CFP. 45-degree field of view:
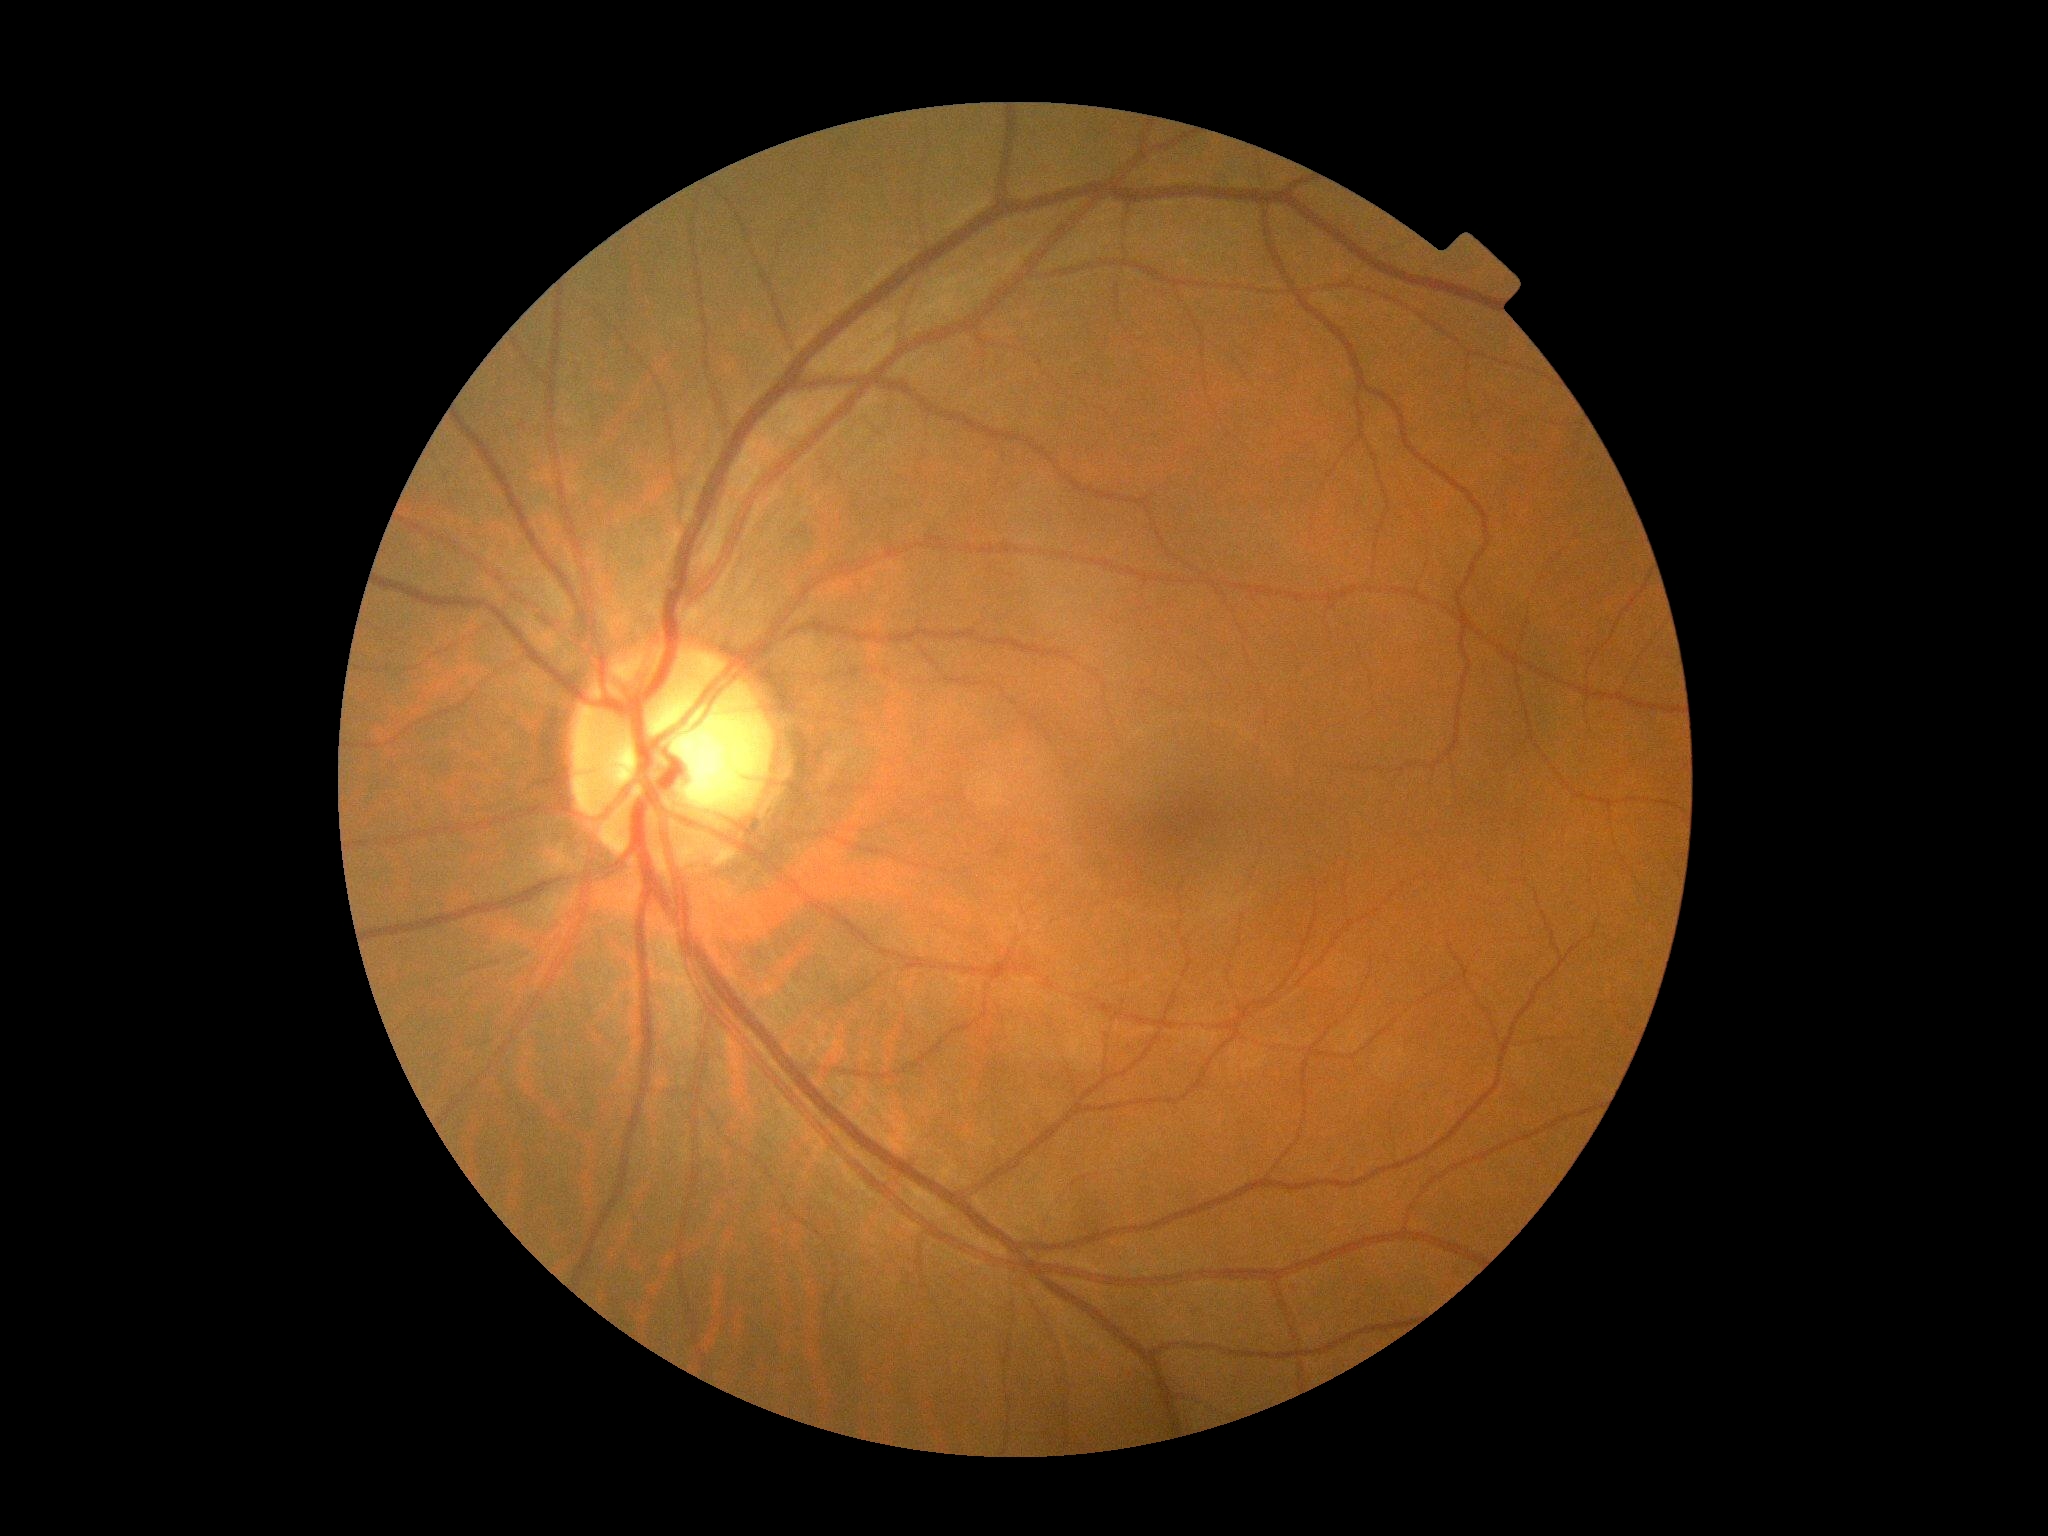

diabetic retinopathy (DR): no apparent retinopathy (grade 0).